Captured with the Clarity RetCam 3 (130° field of view); pediatric retinal photograph (wide-field) — 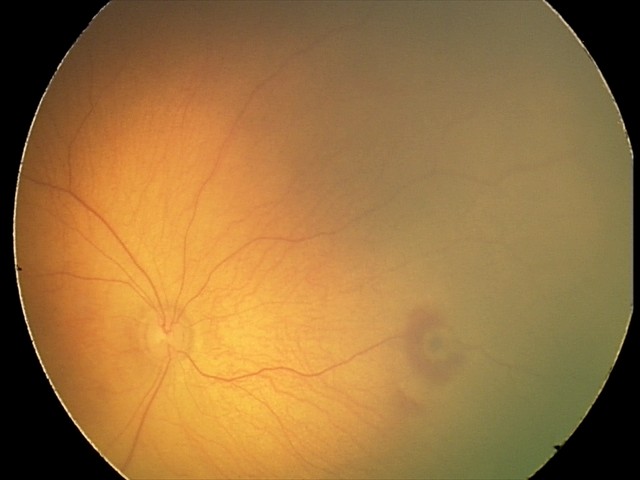

Screening examination consistent with retinal hemorrhages.